45° field of view:
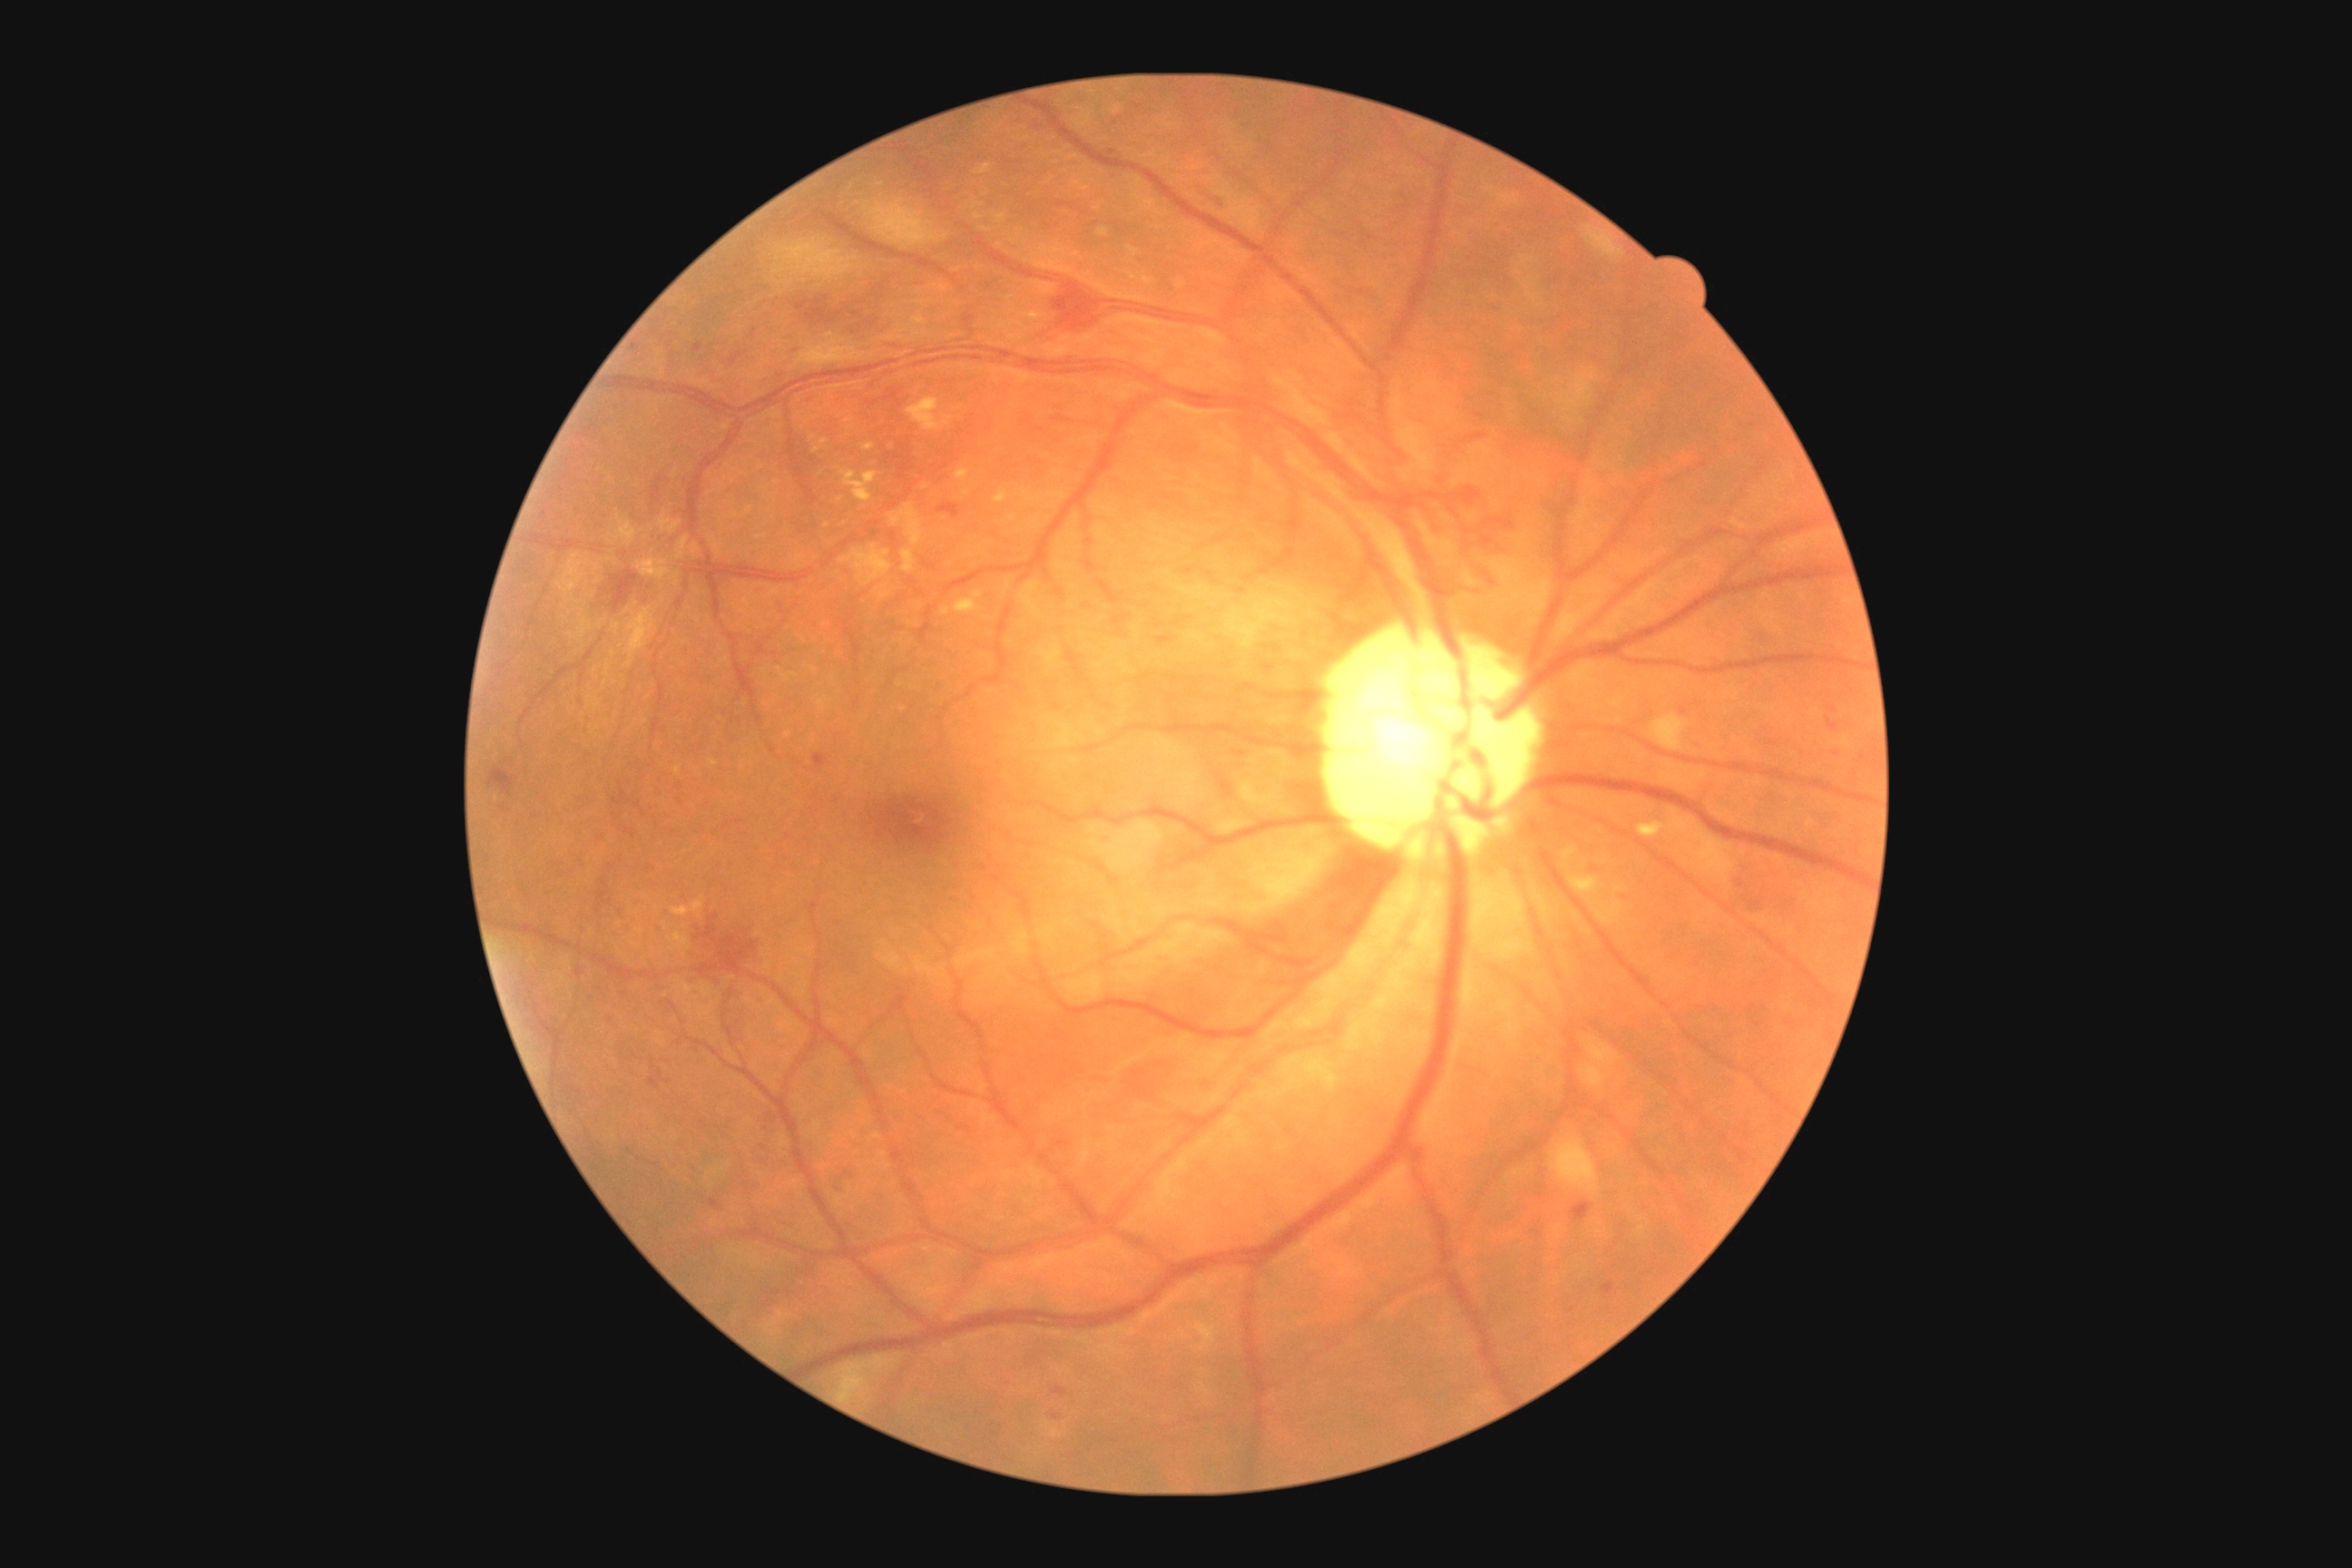
Diabetic retinopathy severity is severe non-proliferative diabetic retinopathy (grade 3) — more than 20 intraretinal hemorrhages in each of 4 quadrants, definite venous beading in 2 or more quadrants, or prominent intraretinal microvascular abnormalities in 1 or more quadrants, with no signs of proliferative retinopathy.